Ultra-widefield fundus photograph: 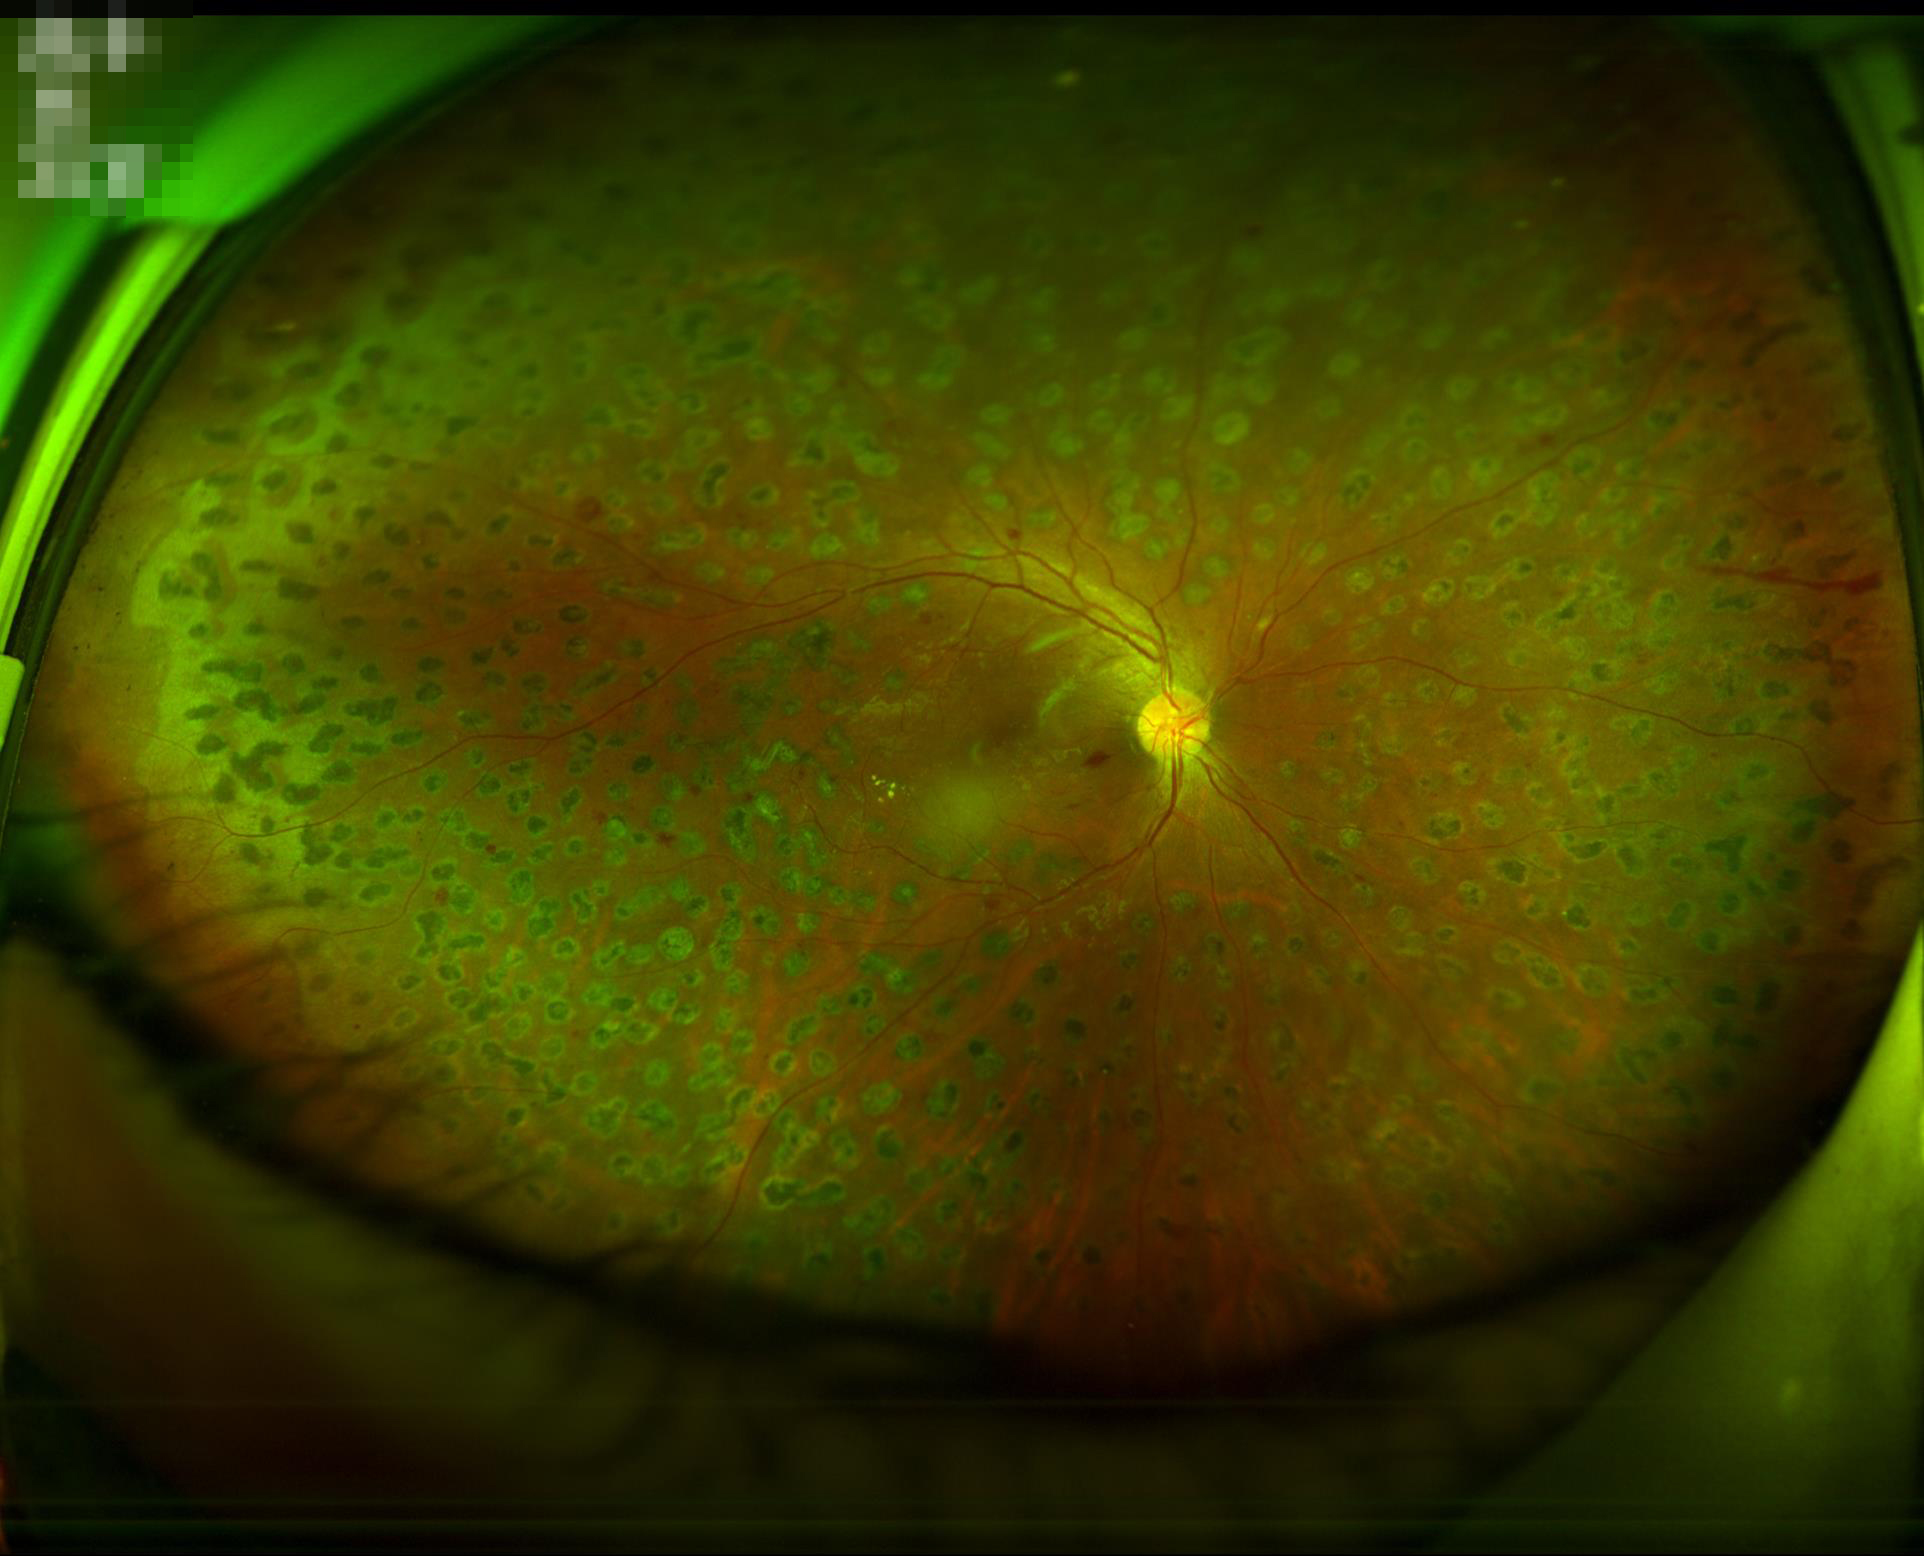 No noticeable blur.
Even illumination with no color cast.
Acceptable image quality.
Vessels and details are readily distinguishable.